Image size 240x240 · non-mydriatic: 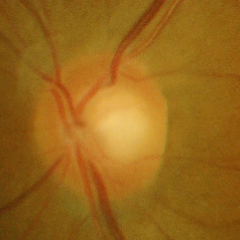
Showing no glaucomatous changes.